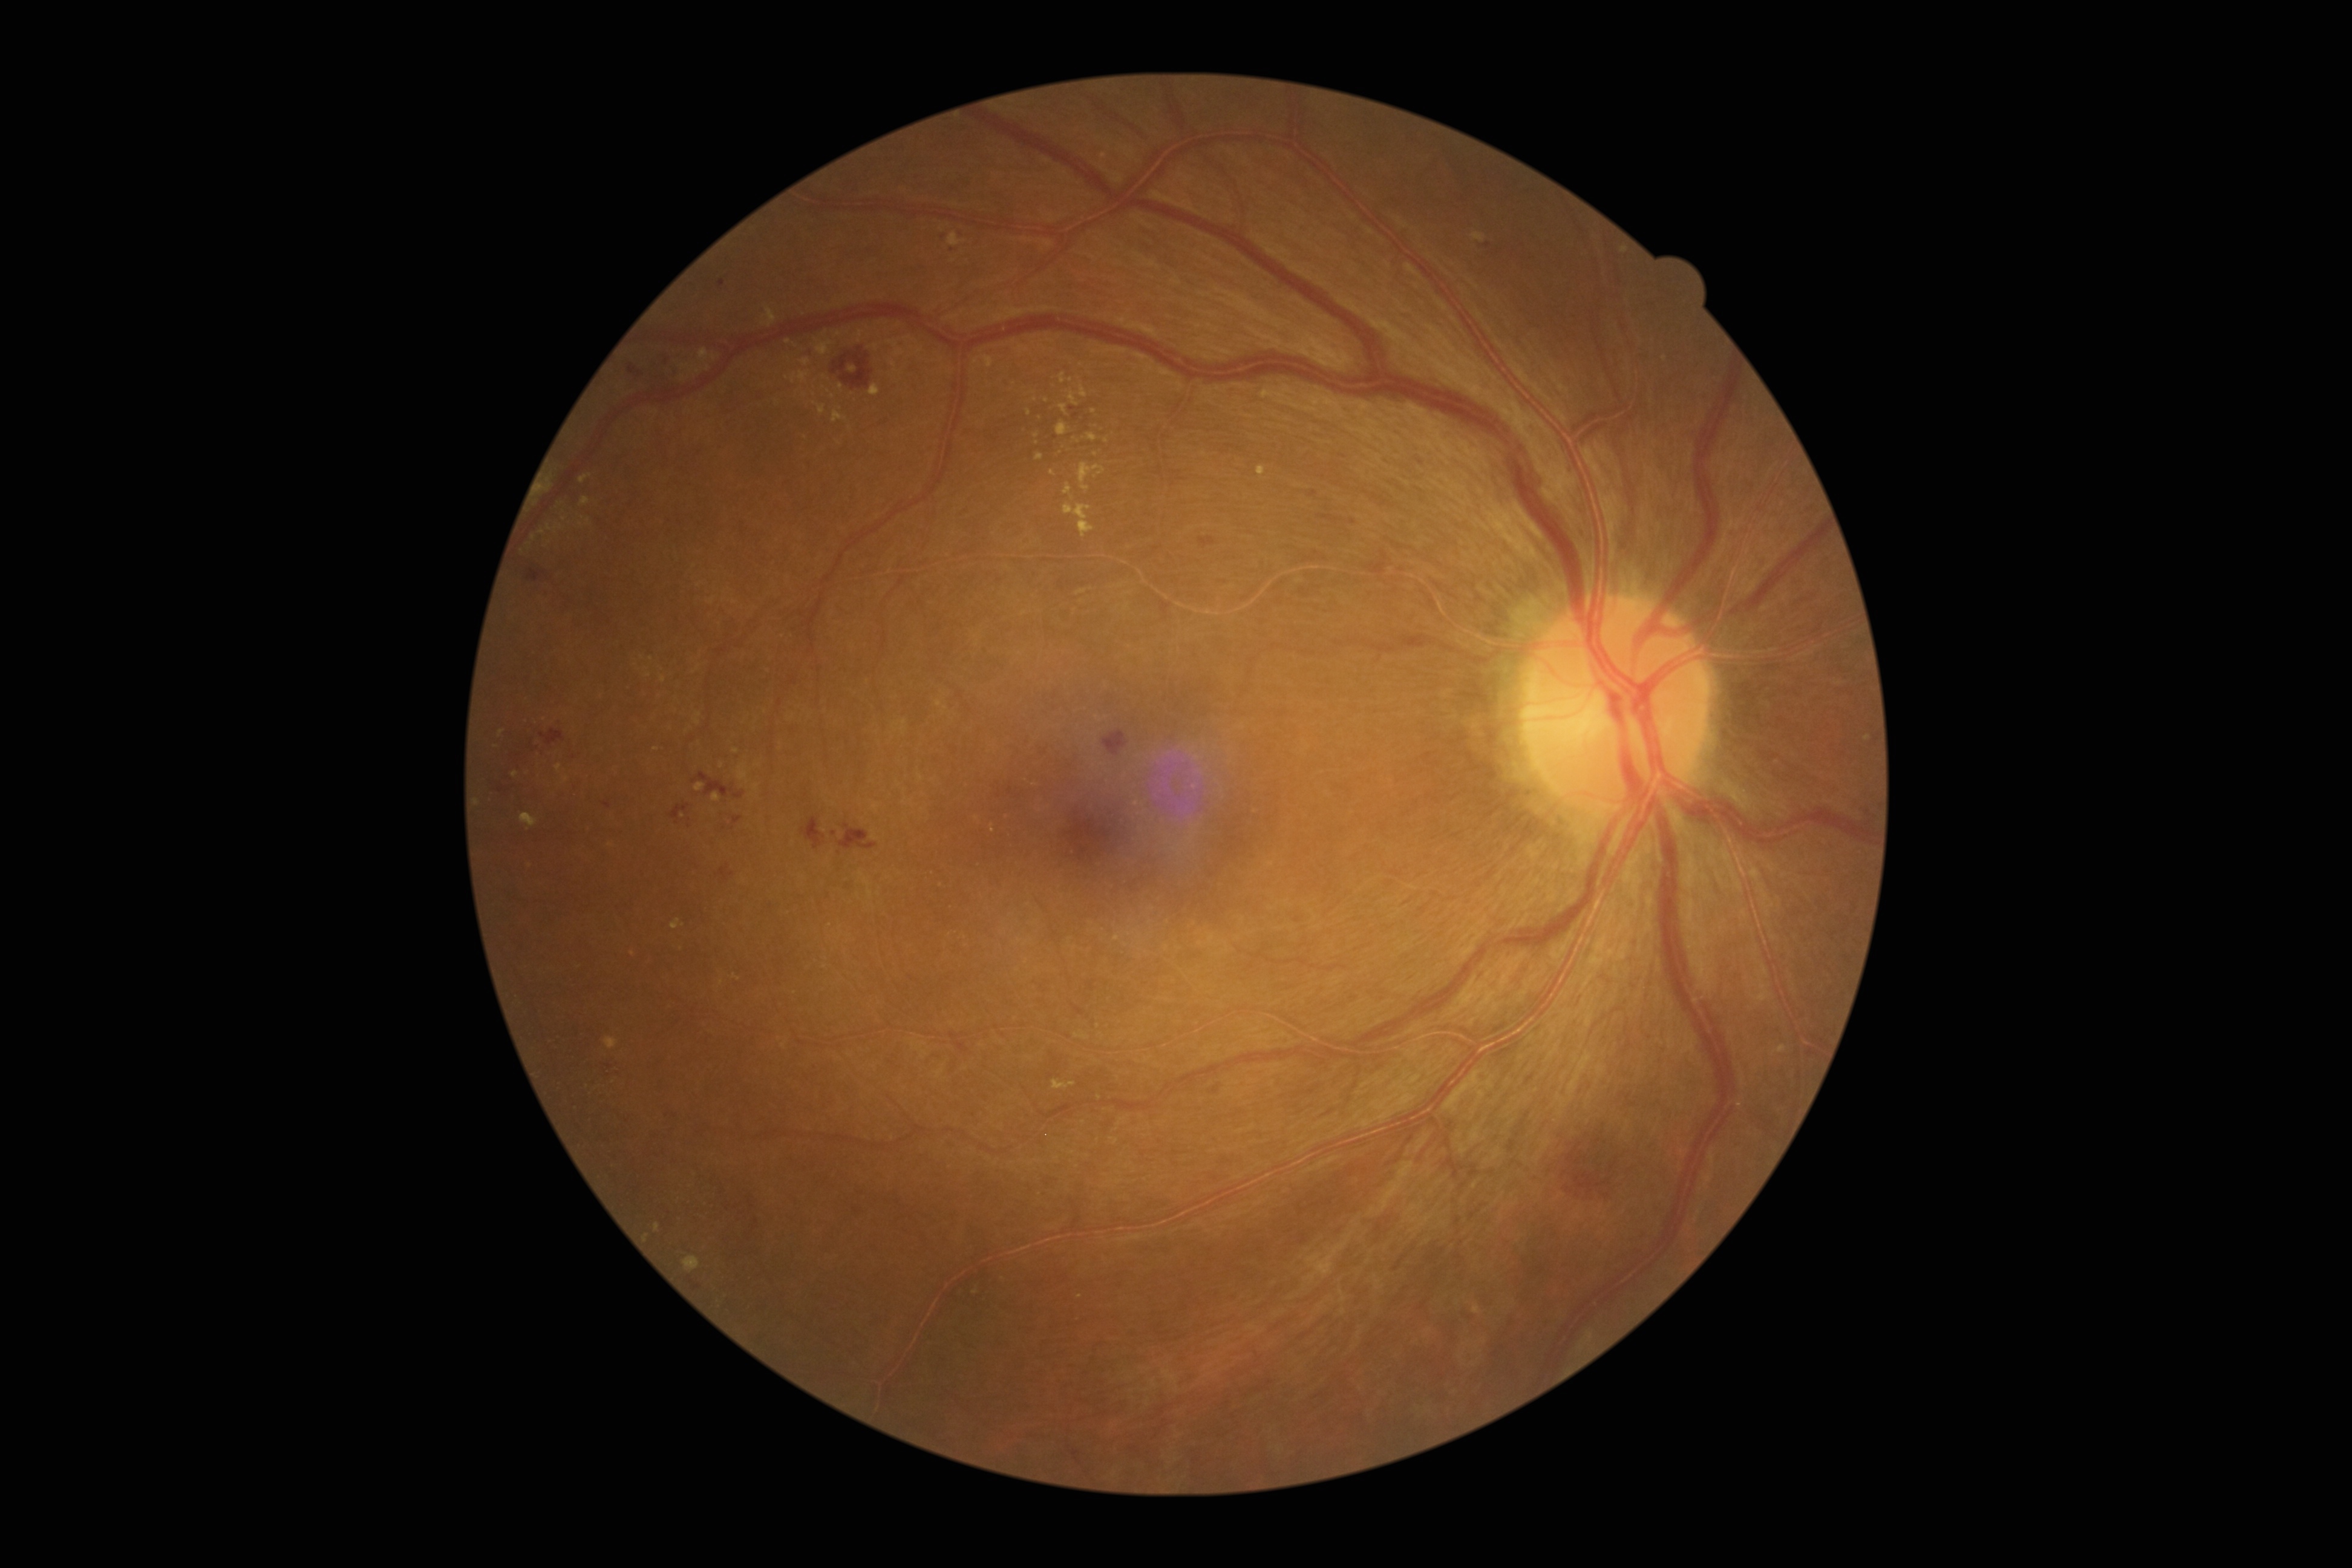 DR grade: 2/4
Selected lesions:
EXs (continued): [x1=699, y1=349, x2=708, y2=361], [x1=654, y1=1224, x2=660, y2=1232], [x1=857, y1=331, x2=863, y2=343], [x1=833, y1=412, x2=846, y2=423], [x1=580, y1=498, x2=591, y2=506], [x1=800, y1=360, x2=810, y2=367], [x1=682, y1=1256, x2=700, y2=1273], [x1=671, y1=919, x2=685, y2=931], [x1=948, y1=233, x2=962, y2=247], [x1=737, y1=764, x2=750, y2=785]
Small EXs approximately at point(656, 749), point(646, 1239), point(1029, 413), point(1117, 939), point(825, 377), point(683, 816), point(549, 529), point(976, 818), point(853, 369)